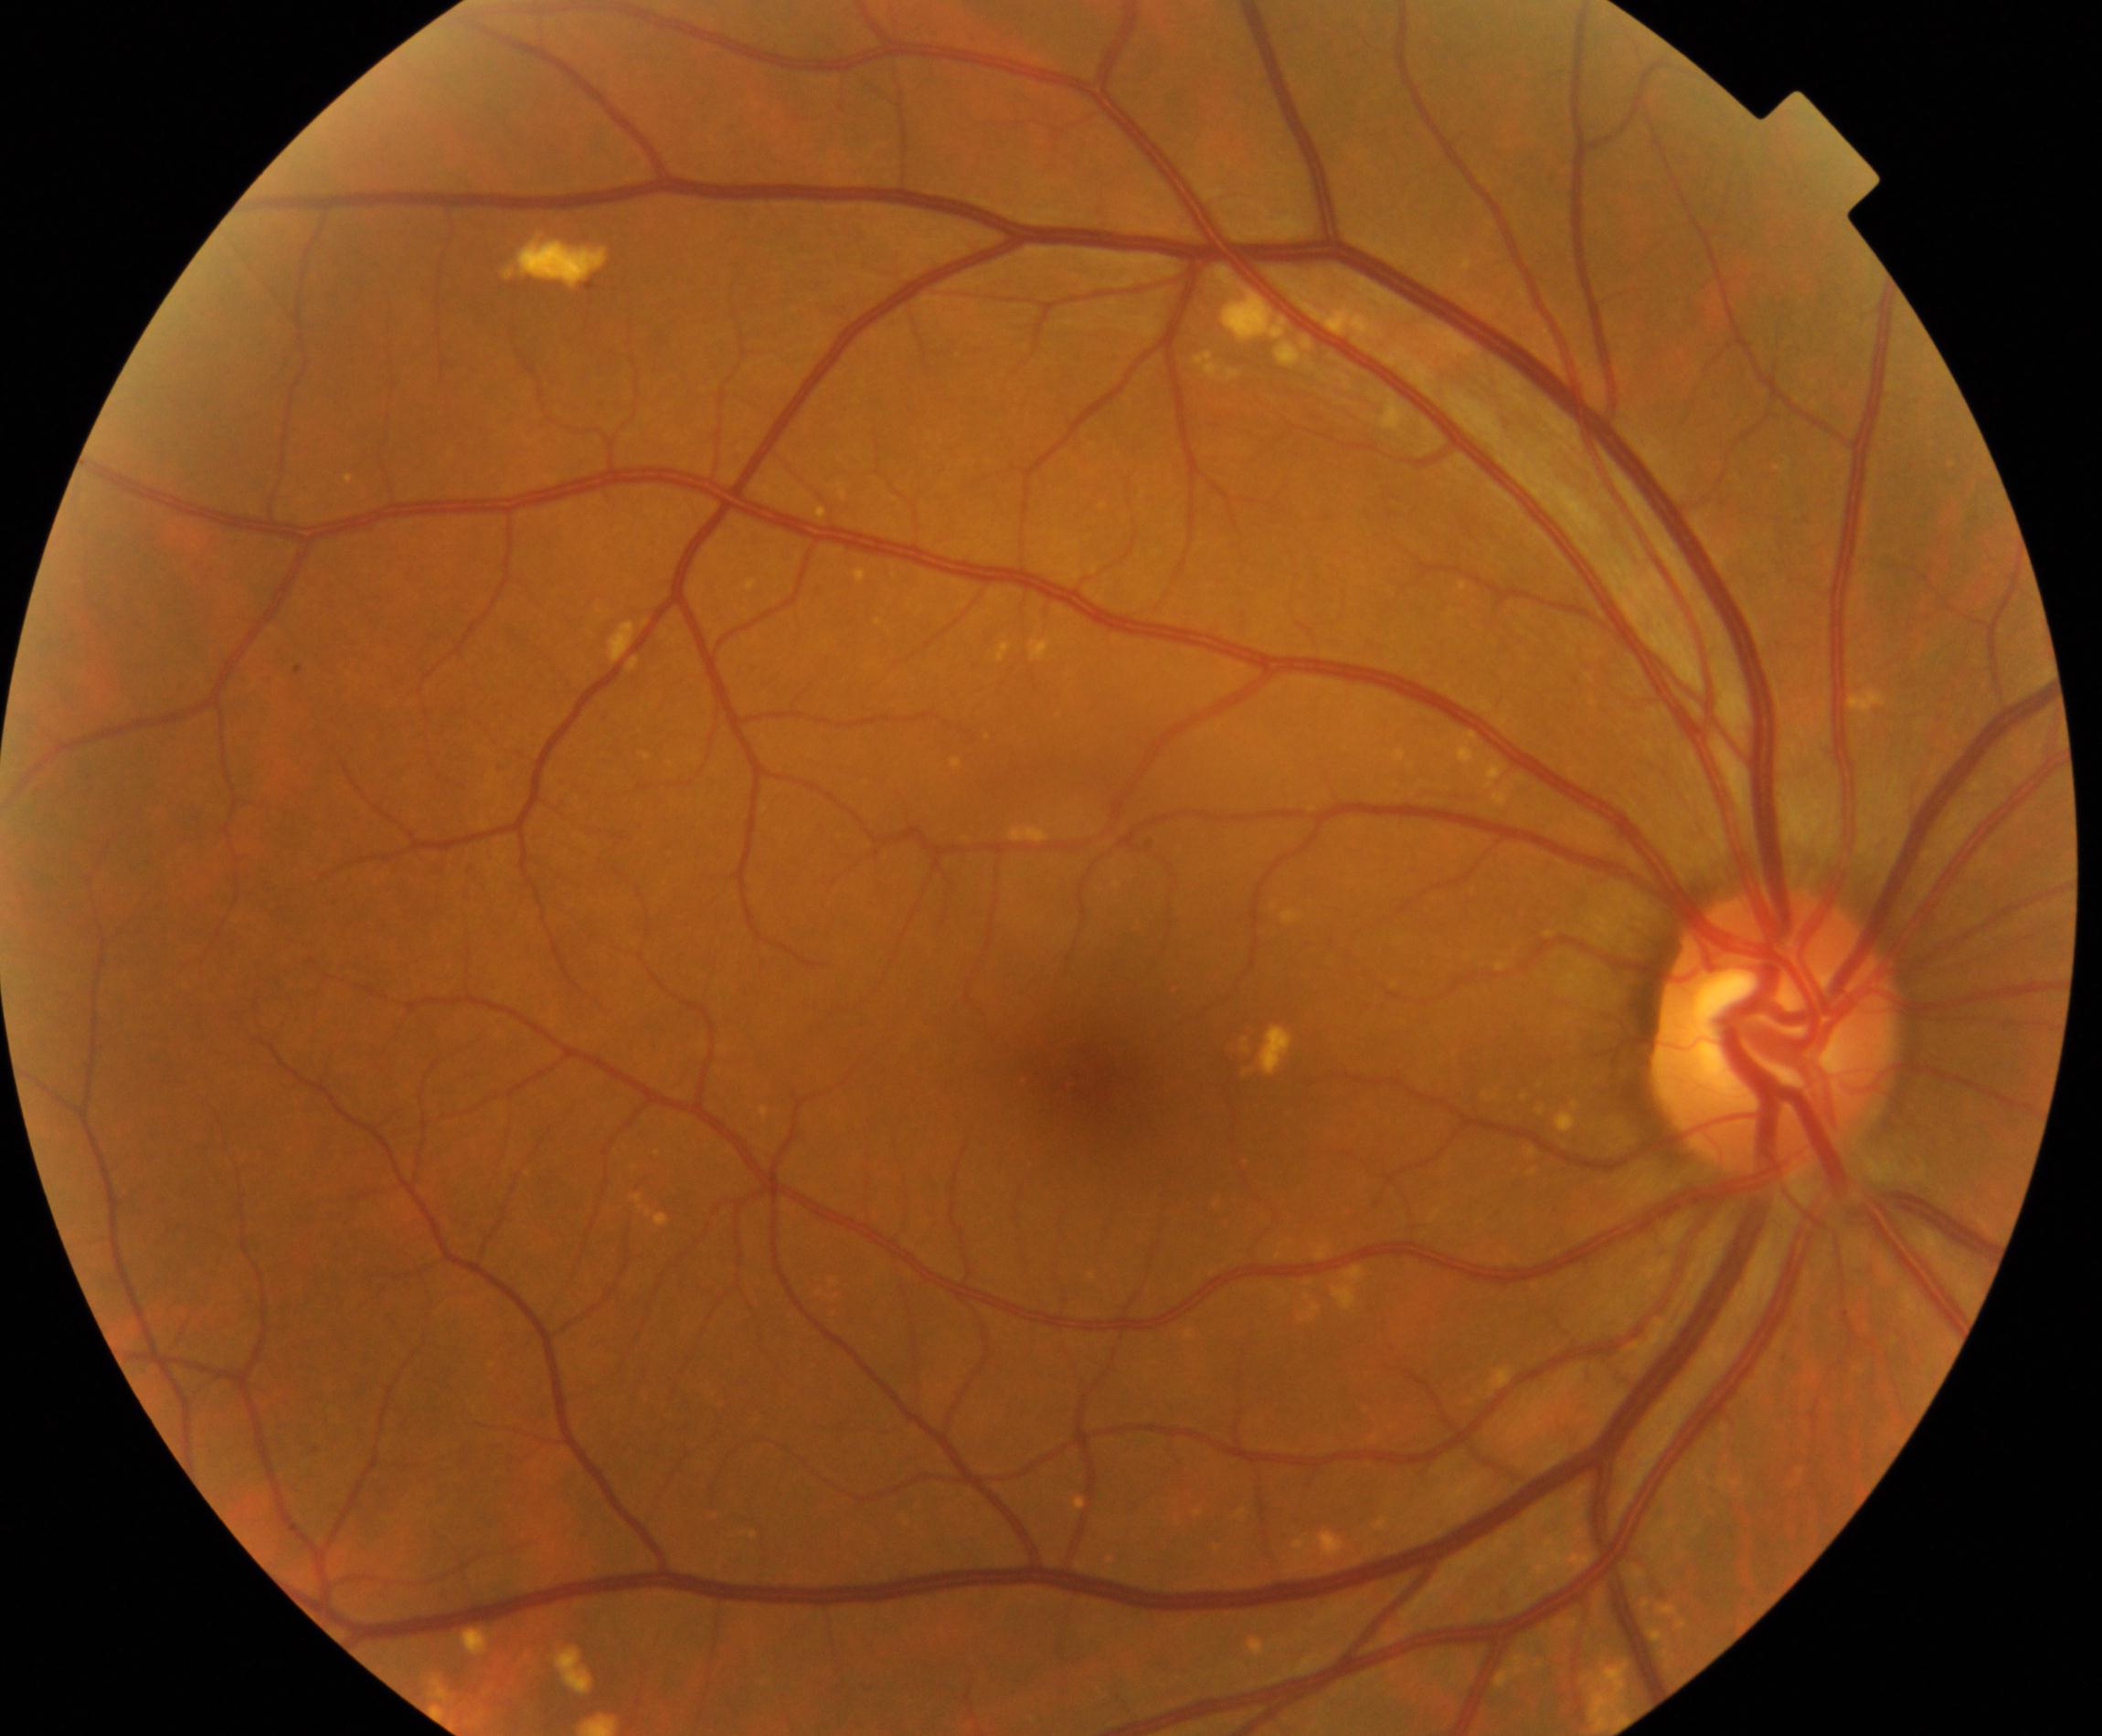

Fundus image consistent with yellow-white spots or flecks.